2212x1659. 60° field of view. Handheld portable fundus camera image.
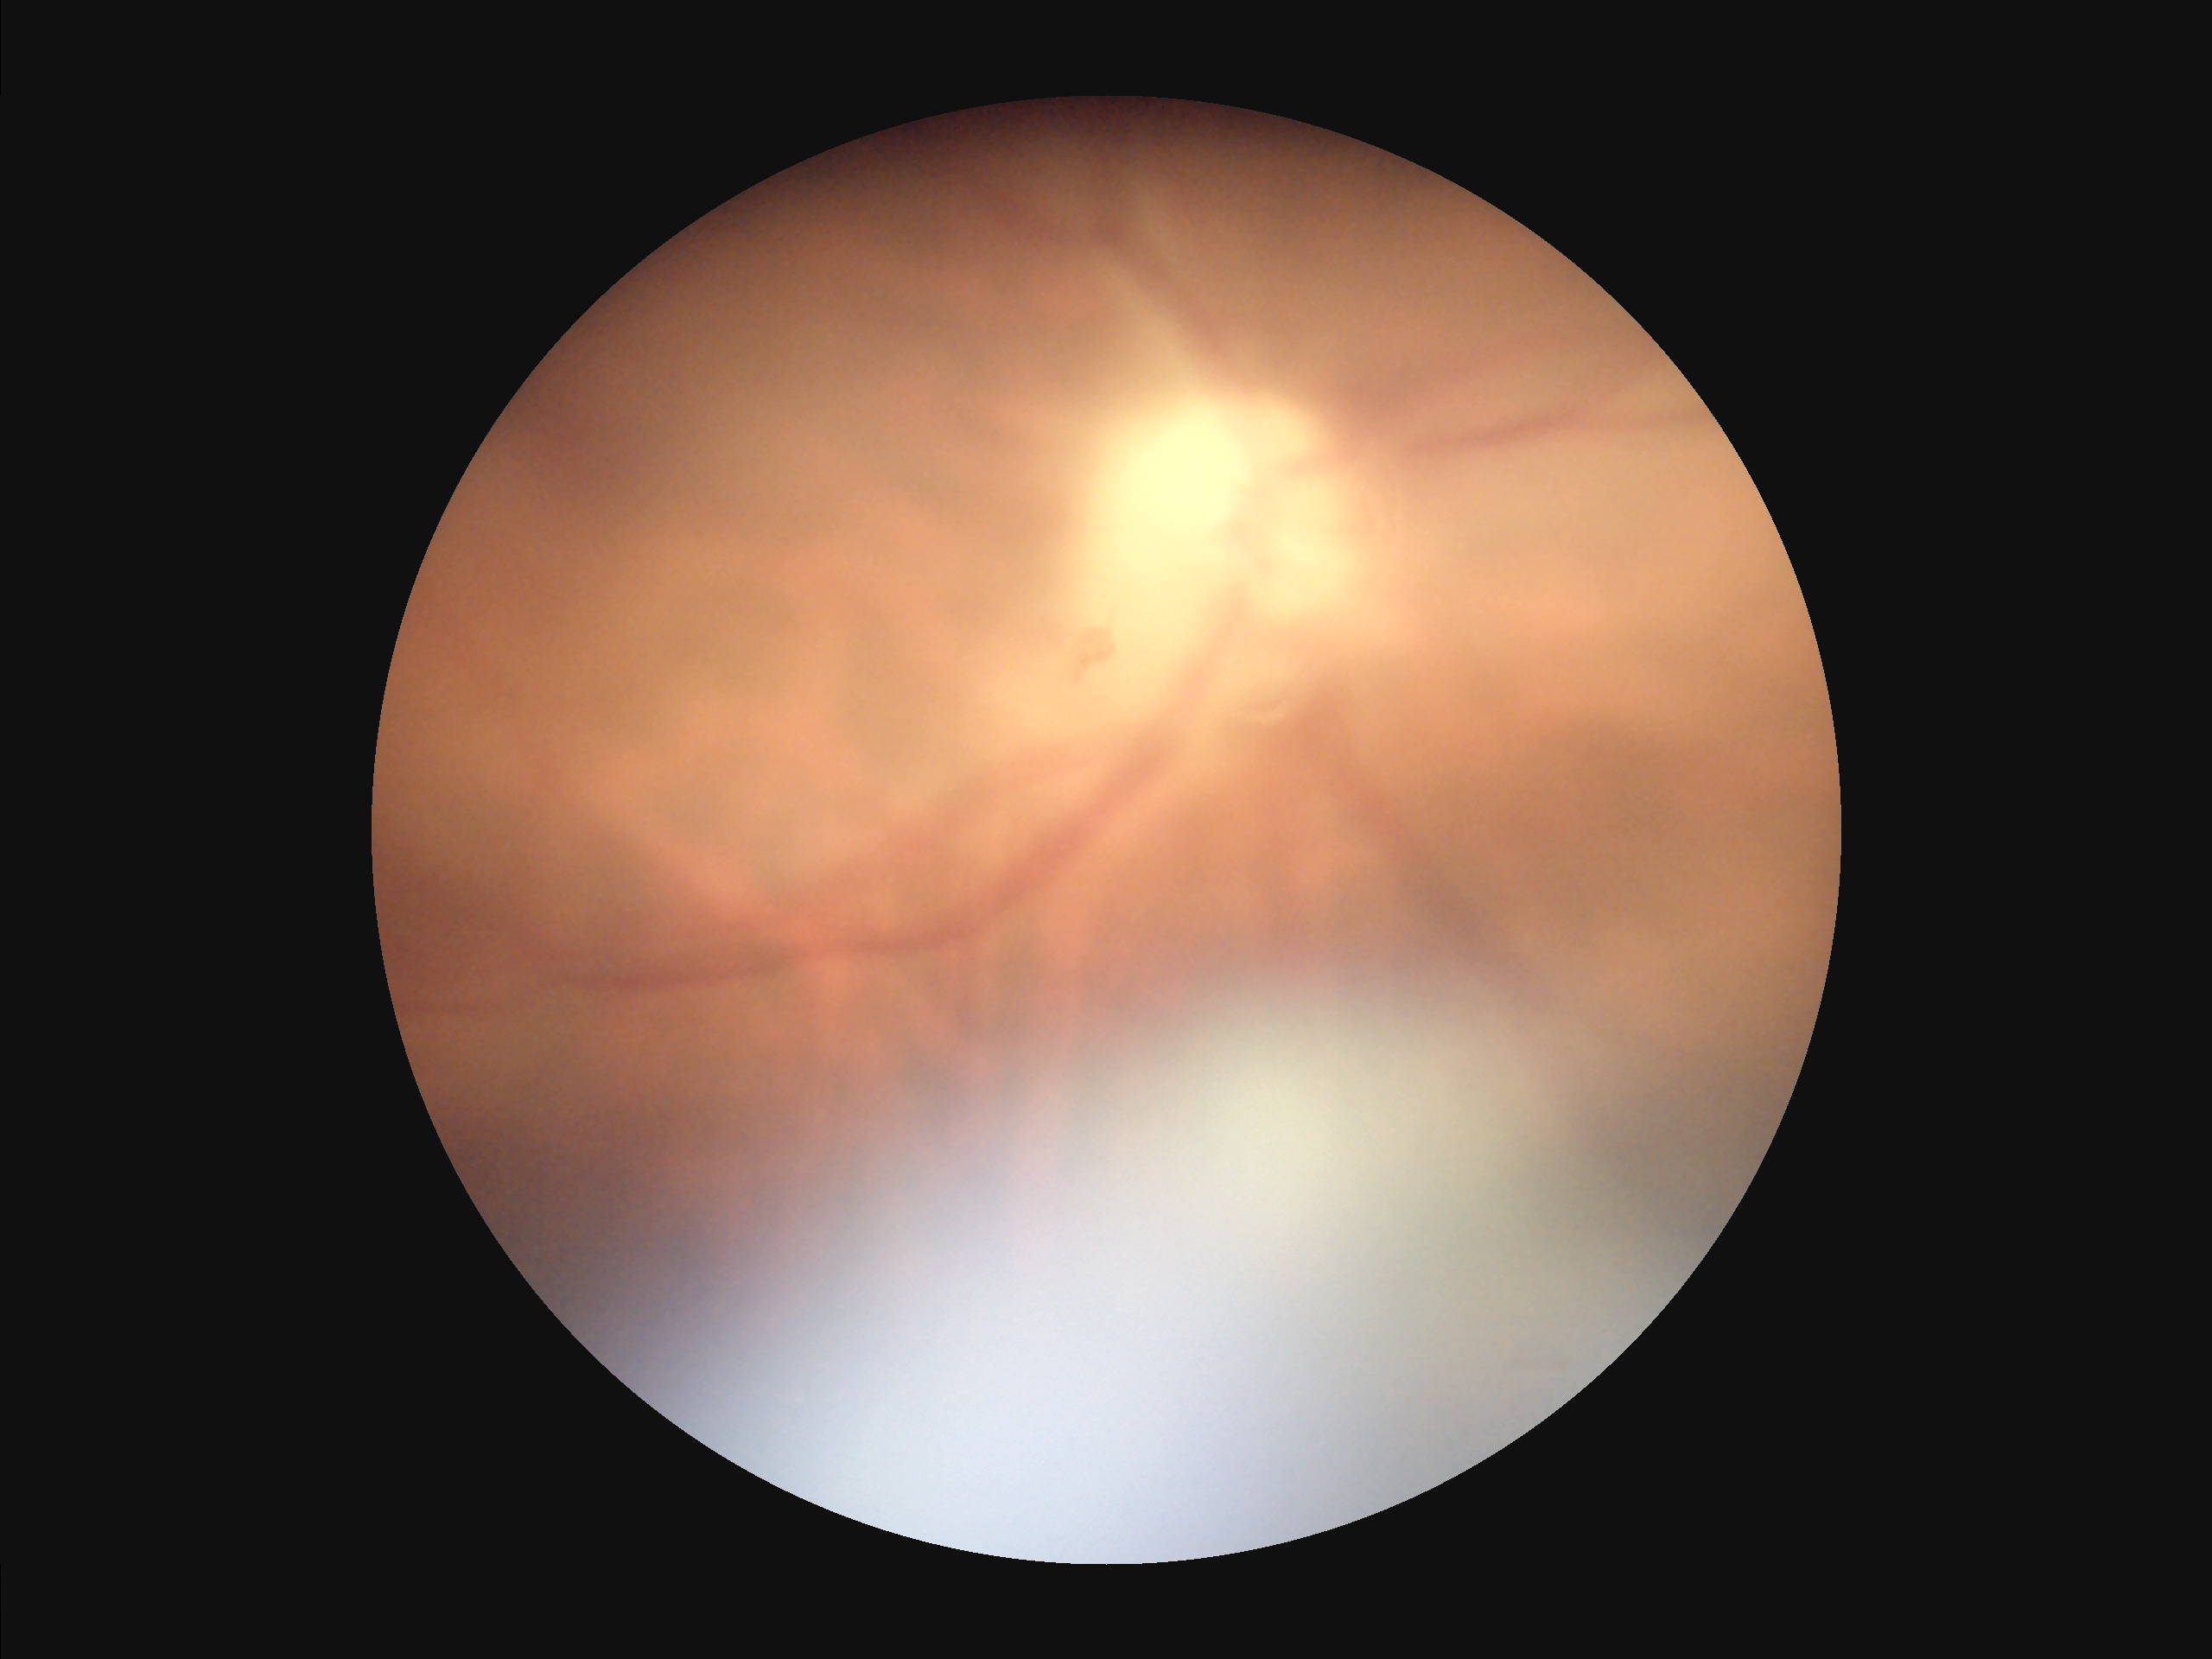

{"overall_quality": "inadequate", "contrast": "reduced", "clarity": "out of focus", "illumination": "poor"}